CFP; 2352 by 1568 pixels; 45° FOV — 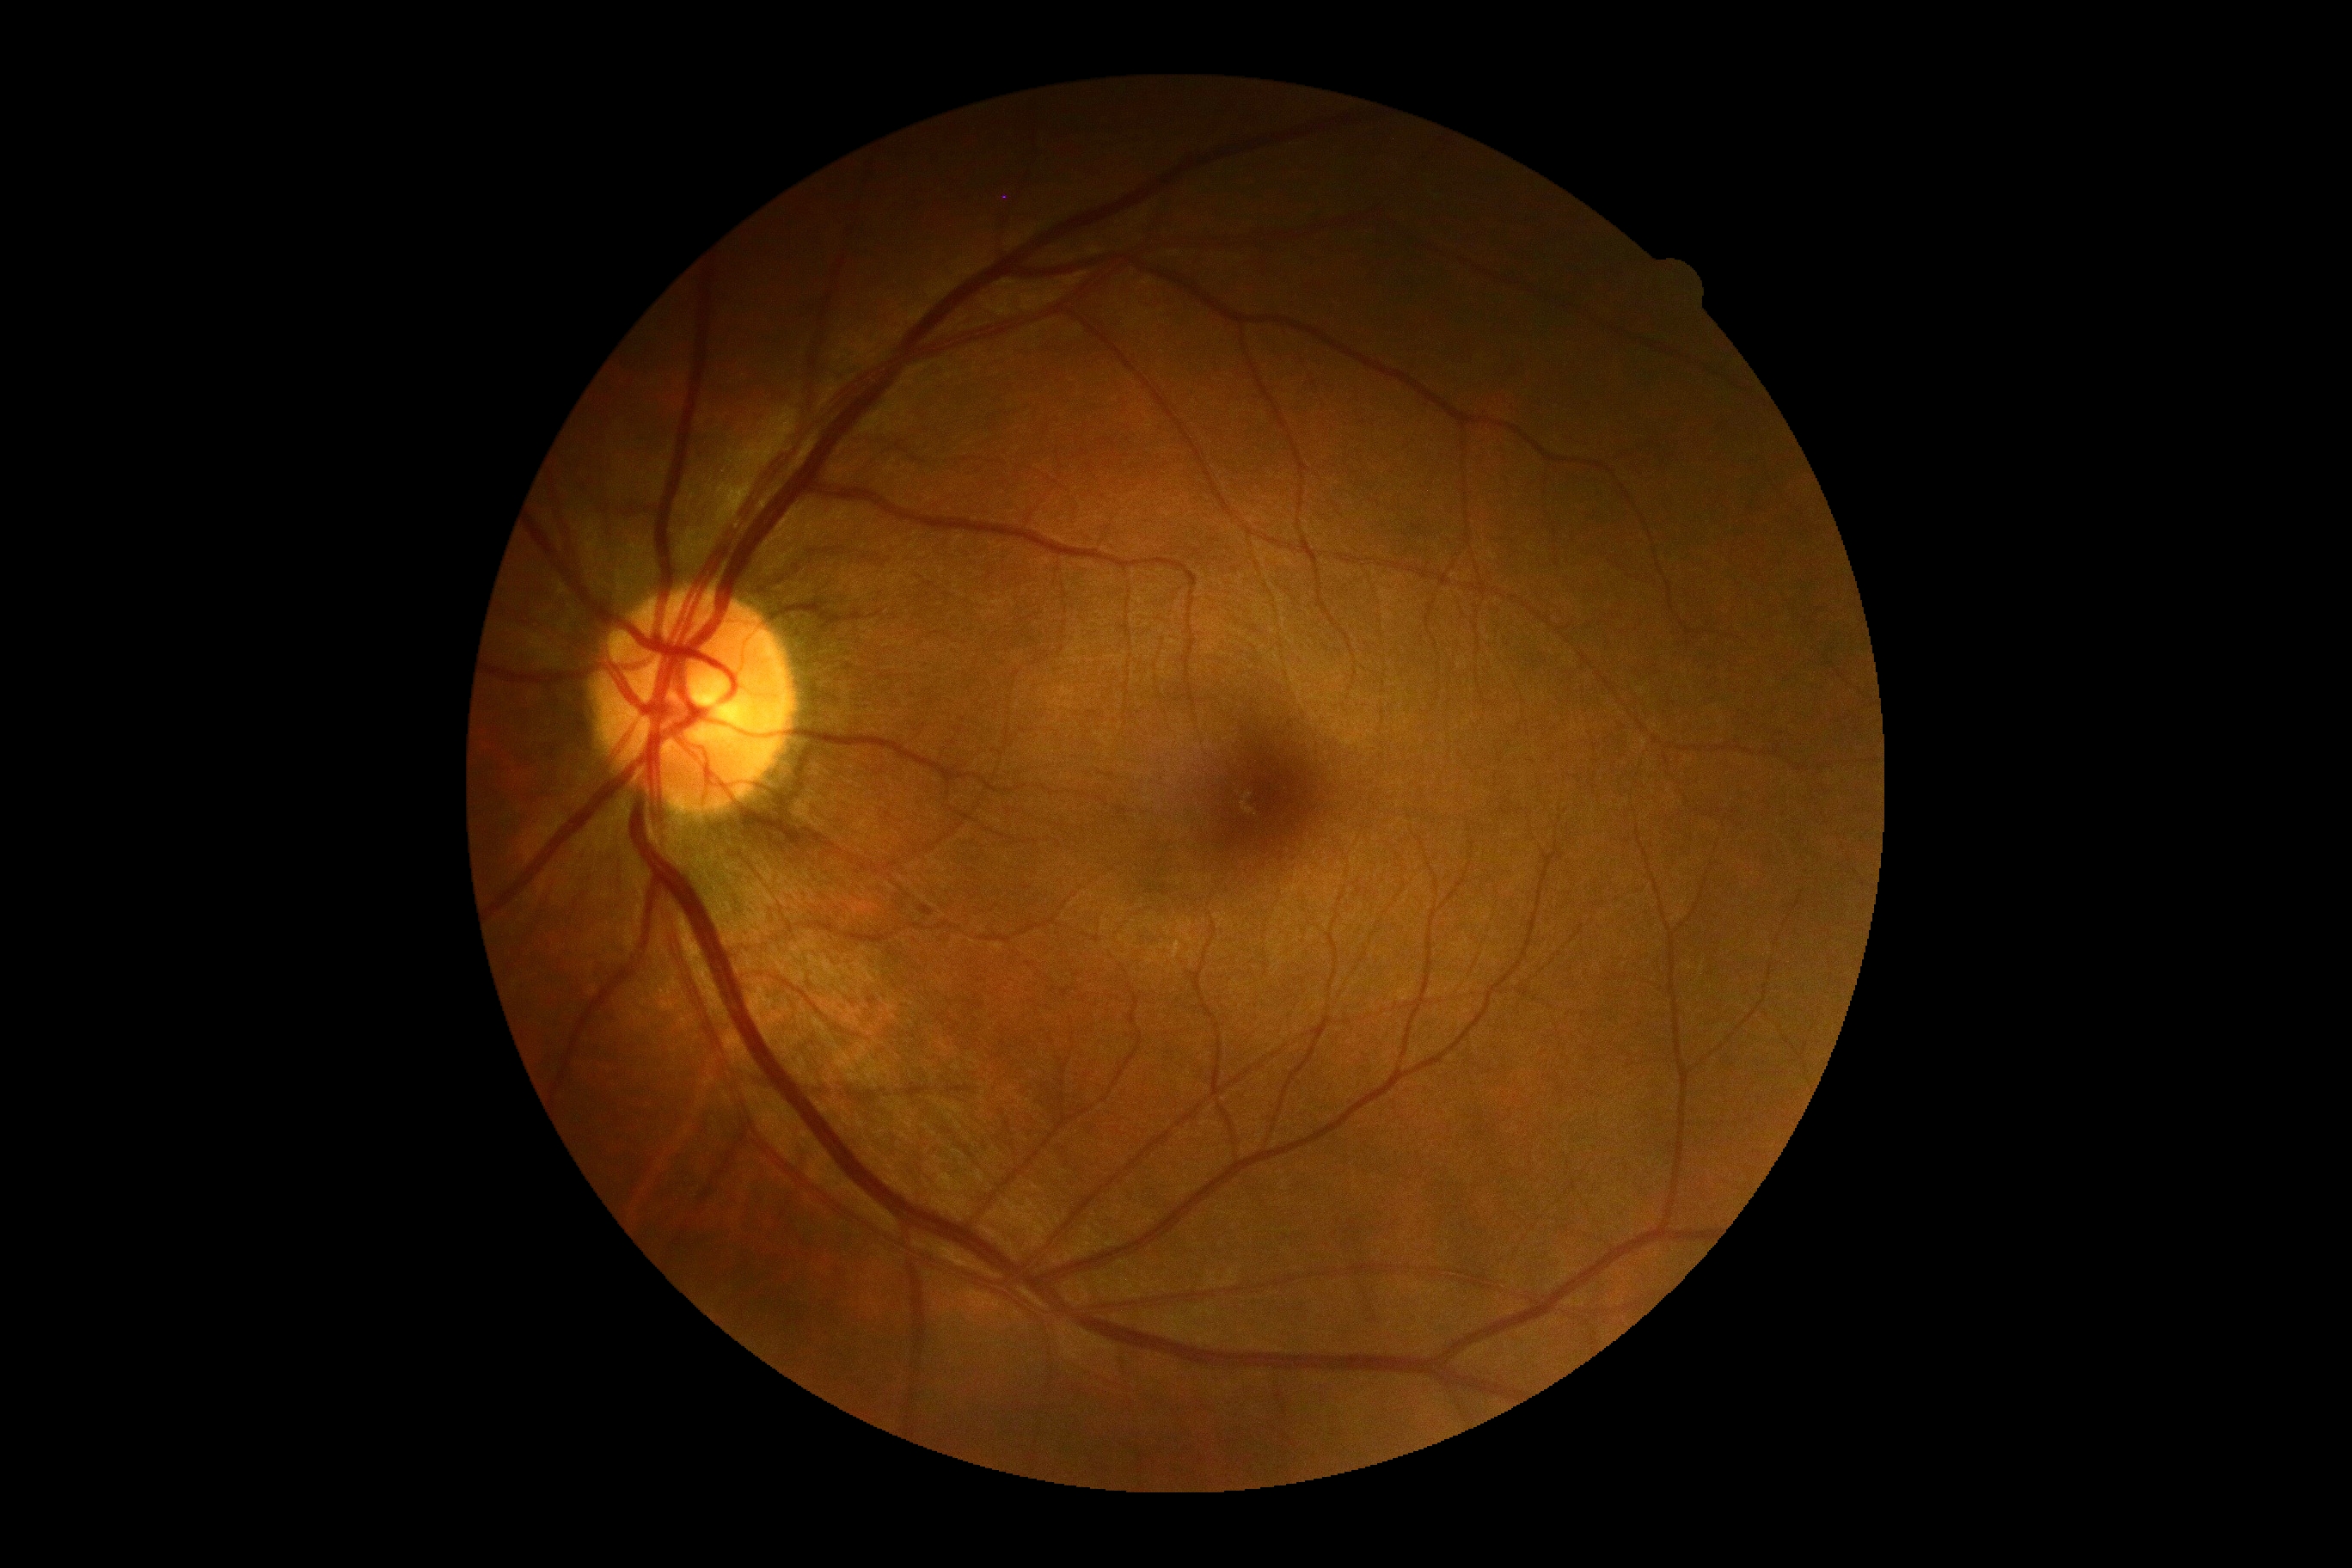
diabetic retinopathy: grade 0